Pediatric wide-field fundus photograph:
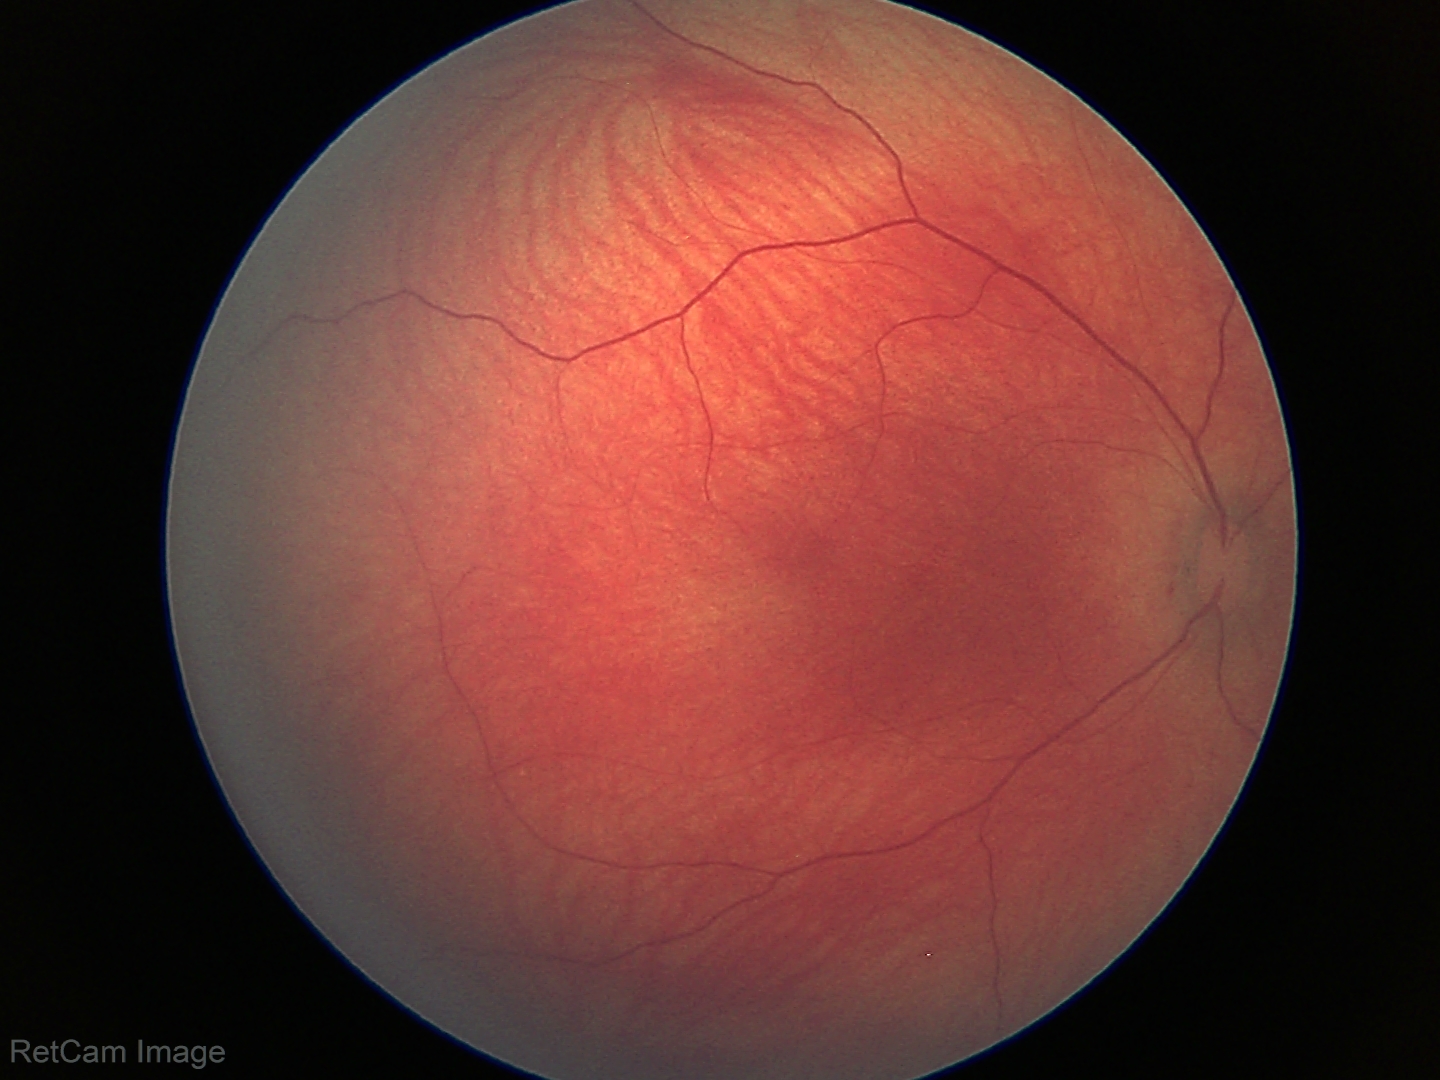 Normal screening examination.